DR severity per modified Davis staging; NIDEK AFC-230 fundus camera; 848 by 848 pixels; 45-degree field of view:
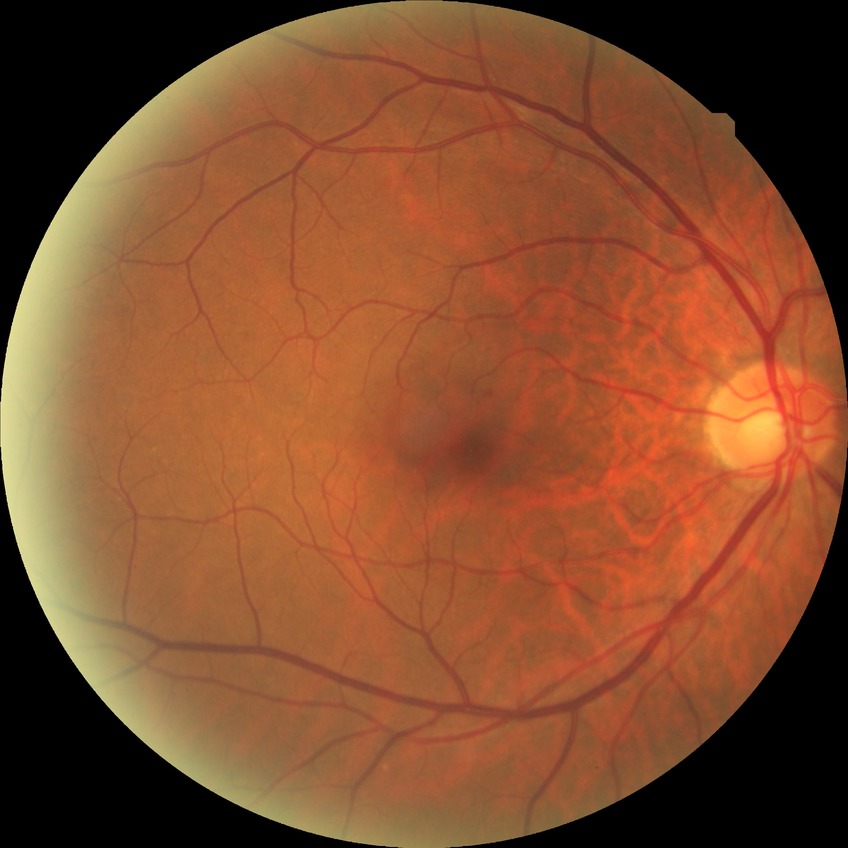

Diabetic retinopathy grade: no diabetic retinopathy.